Color fundus photograph, DR severity per modified Davis staging
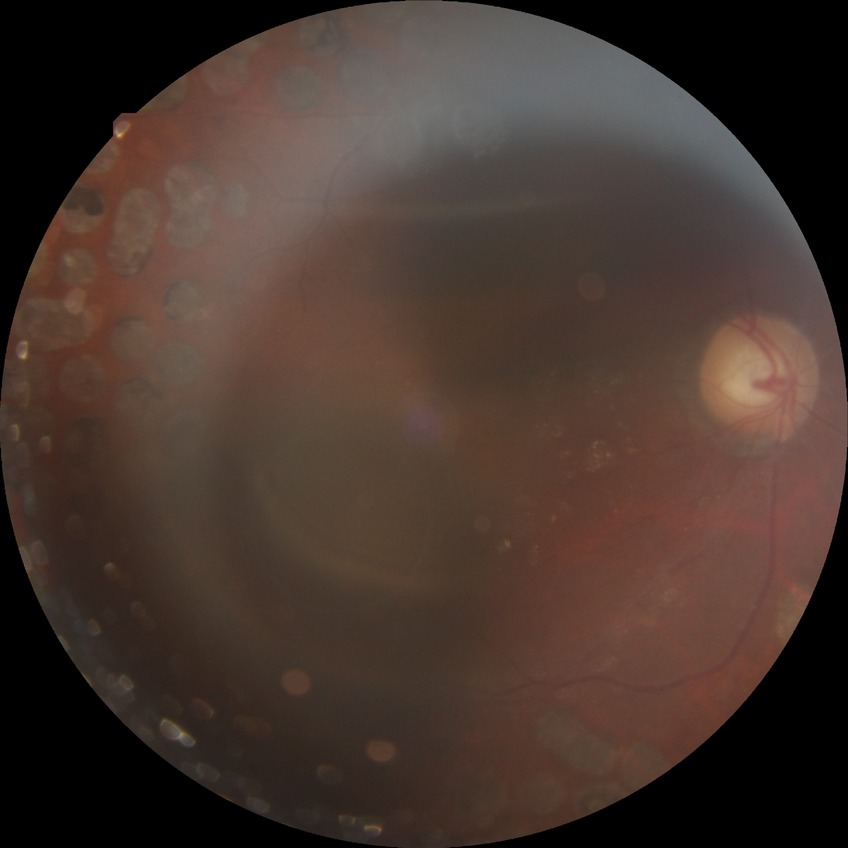
Findings:
– DR stage: PDR